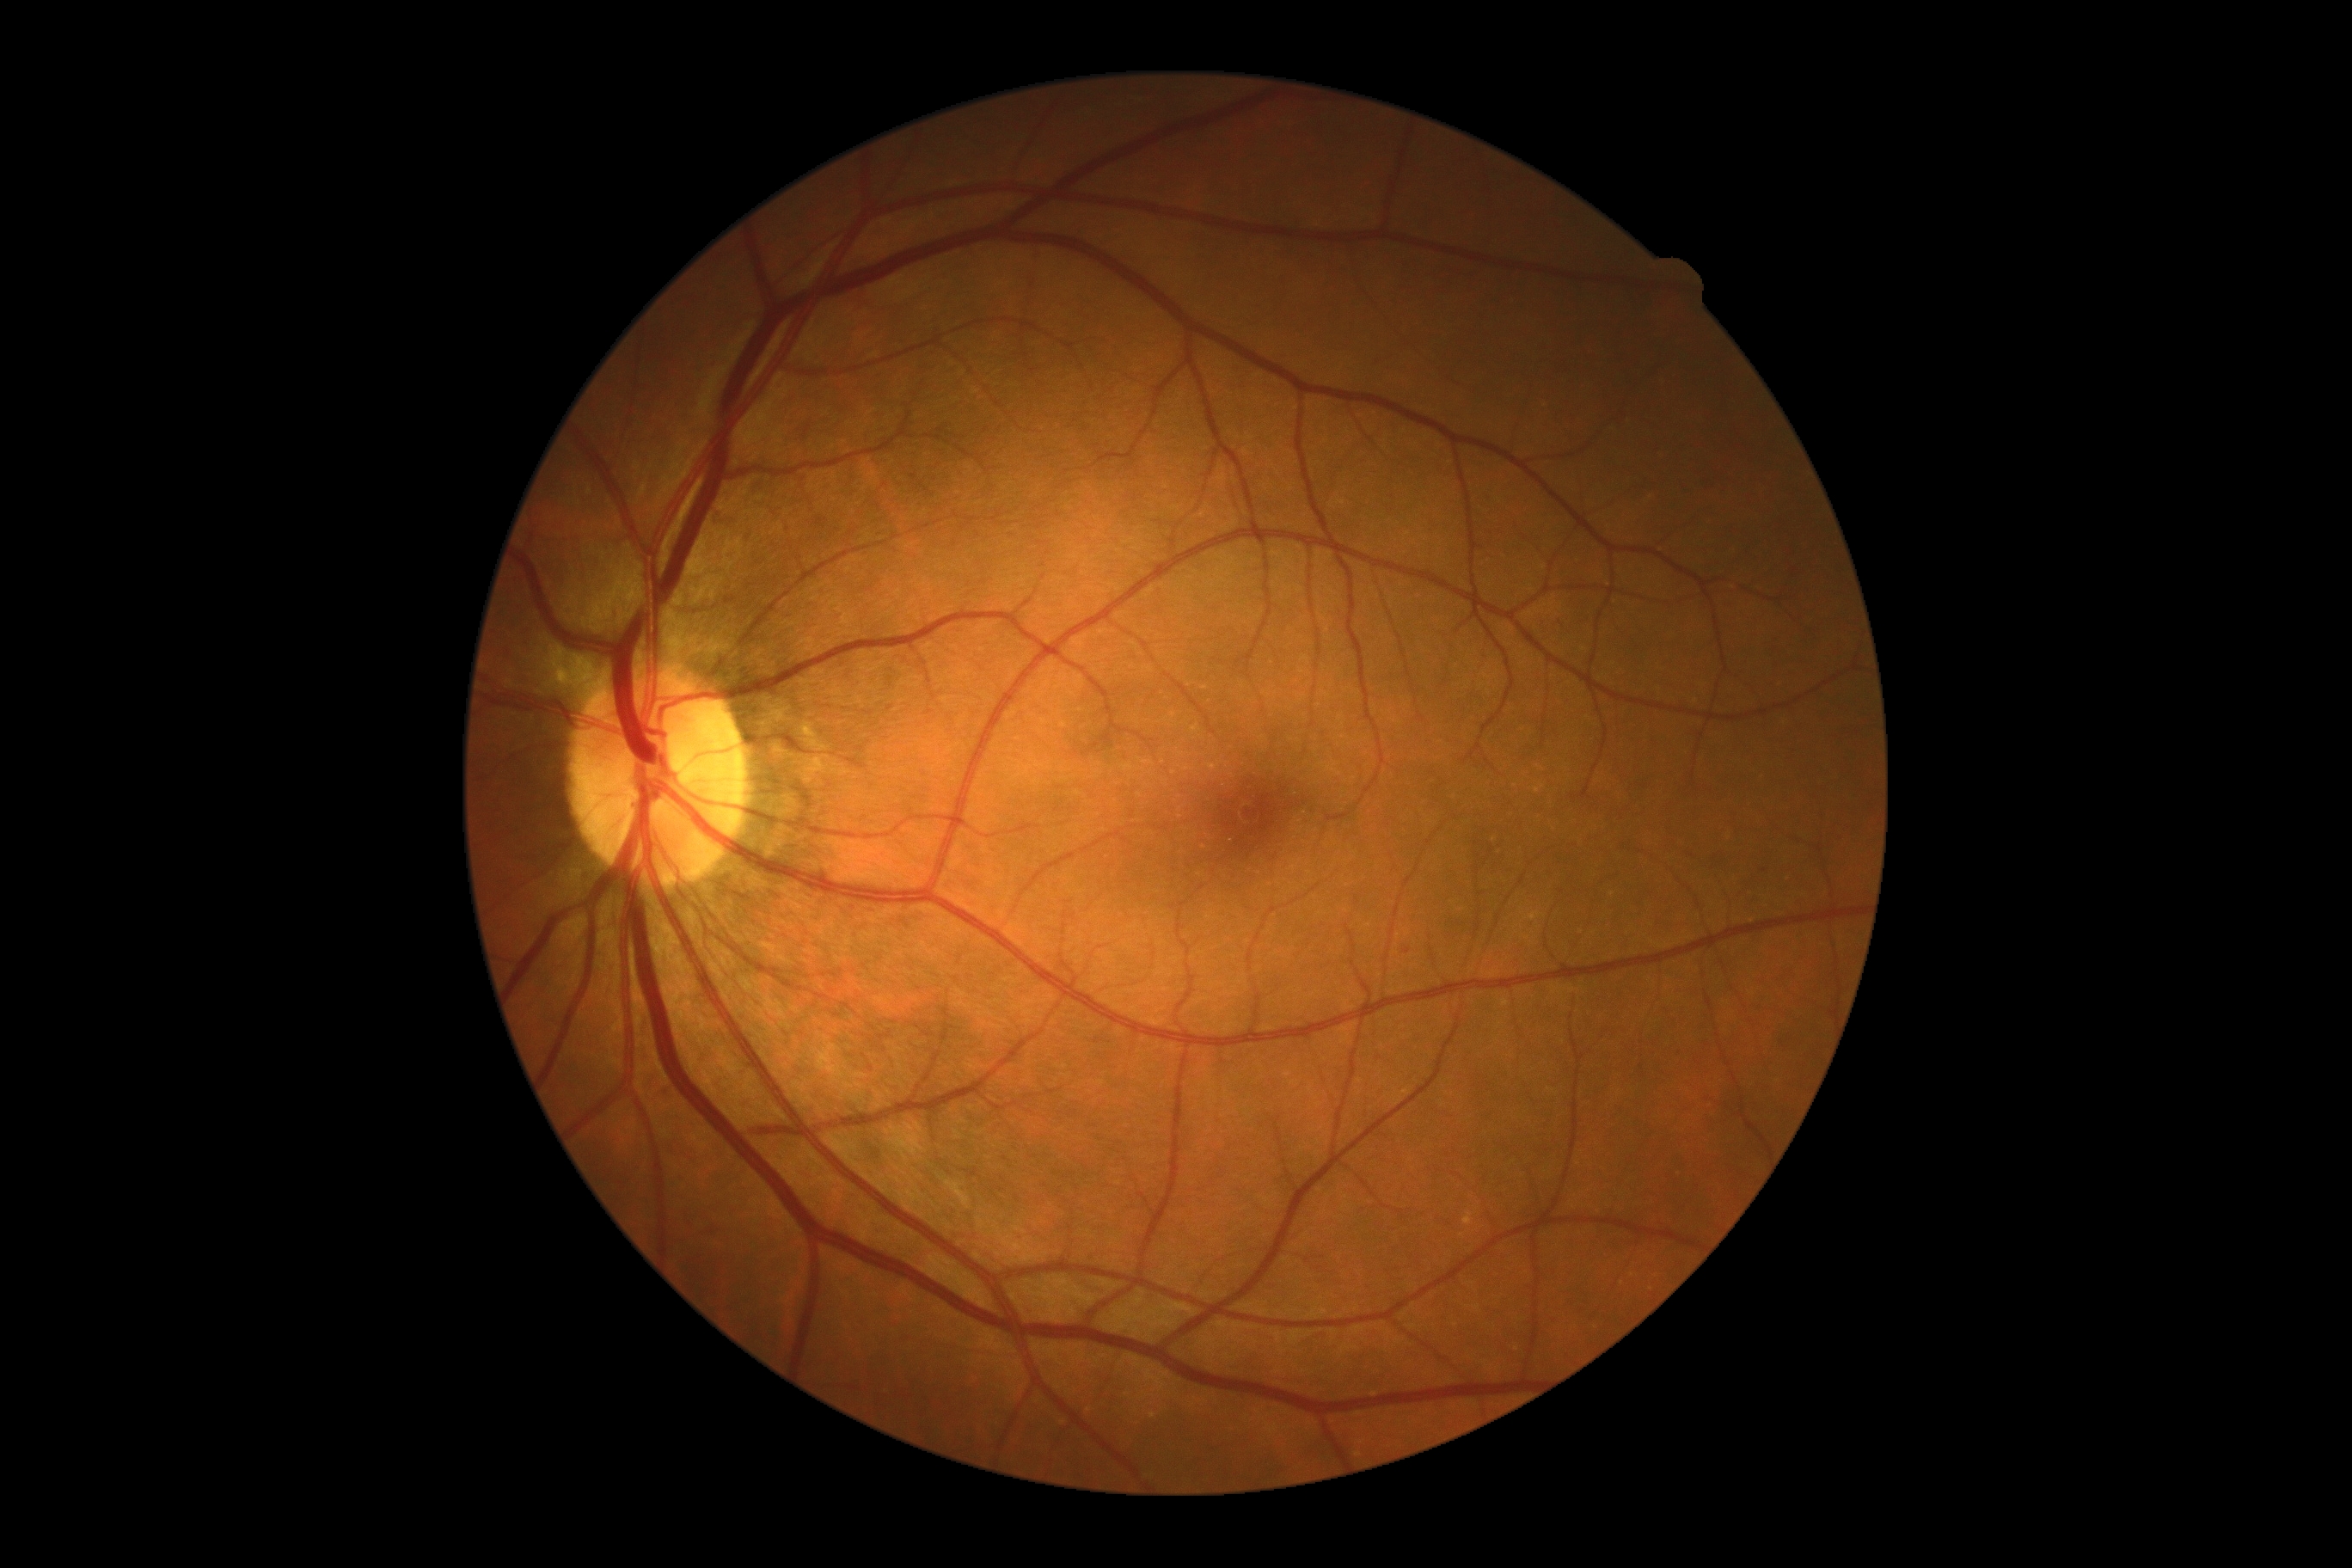 DR stage: 0/4.